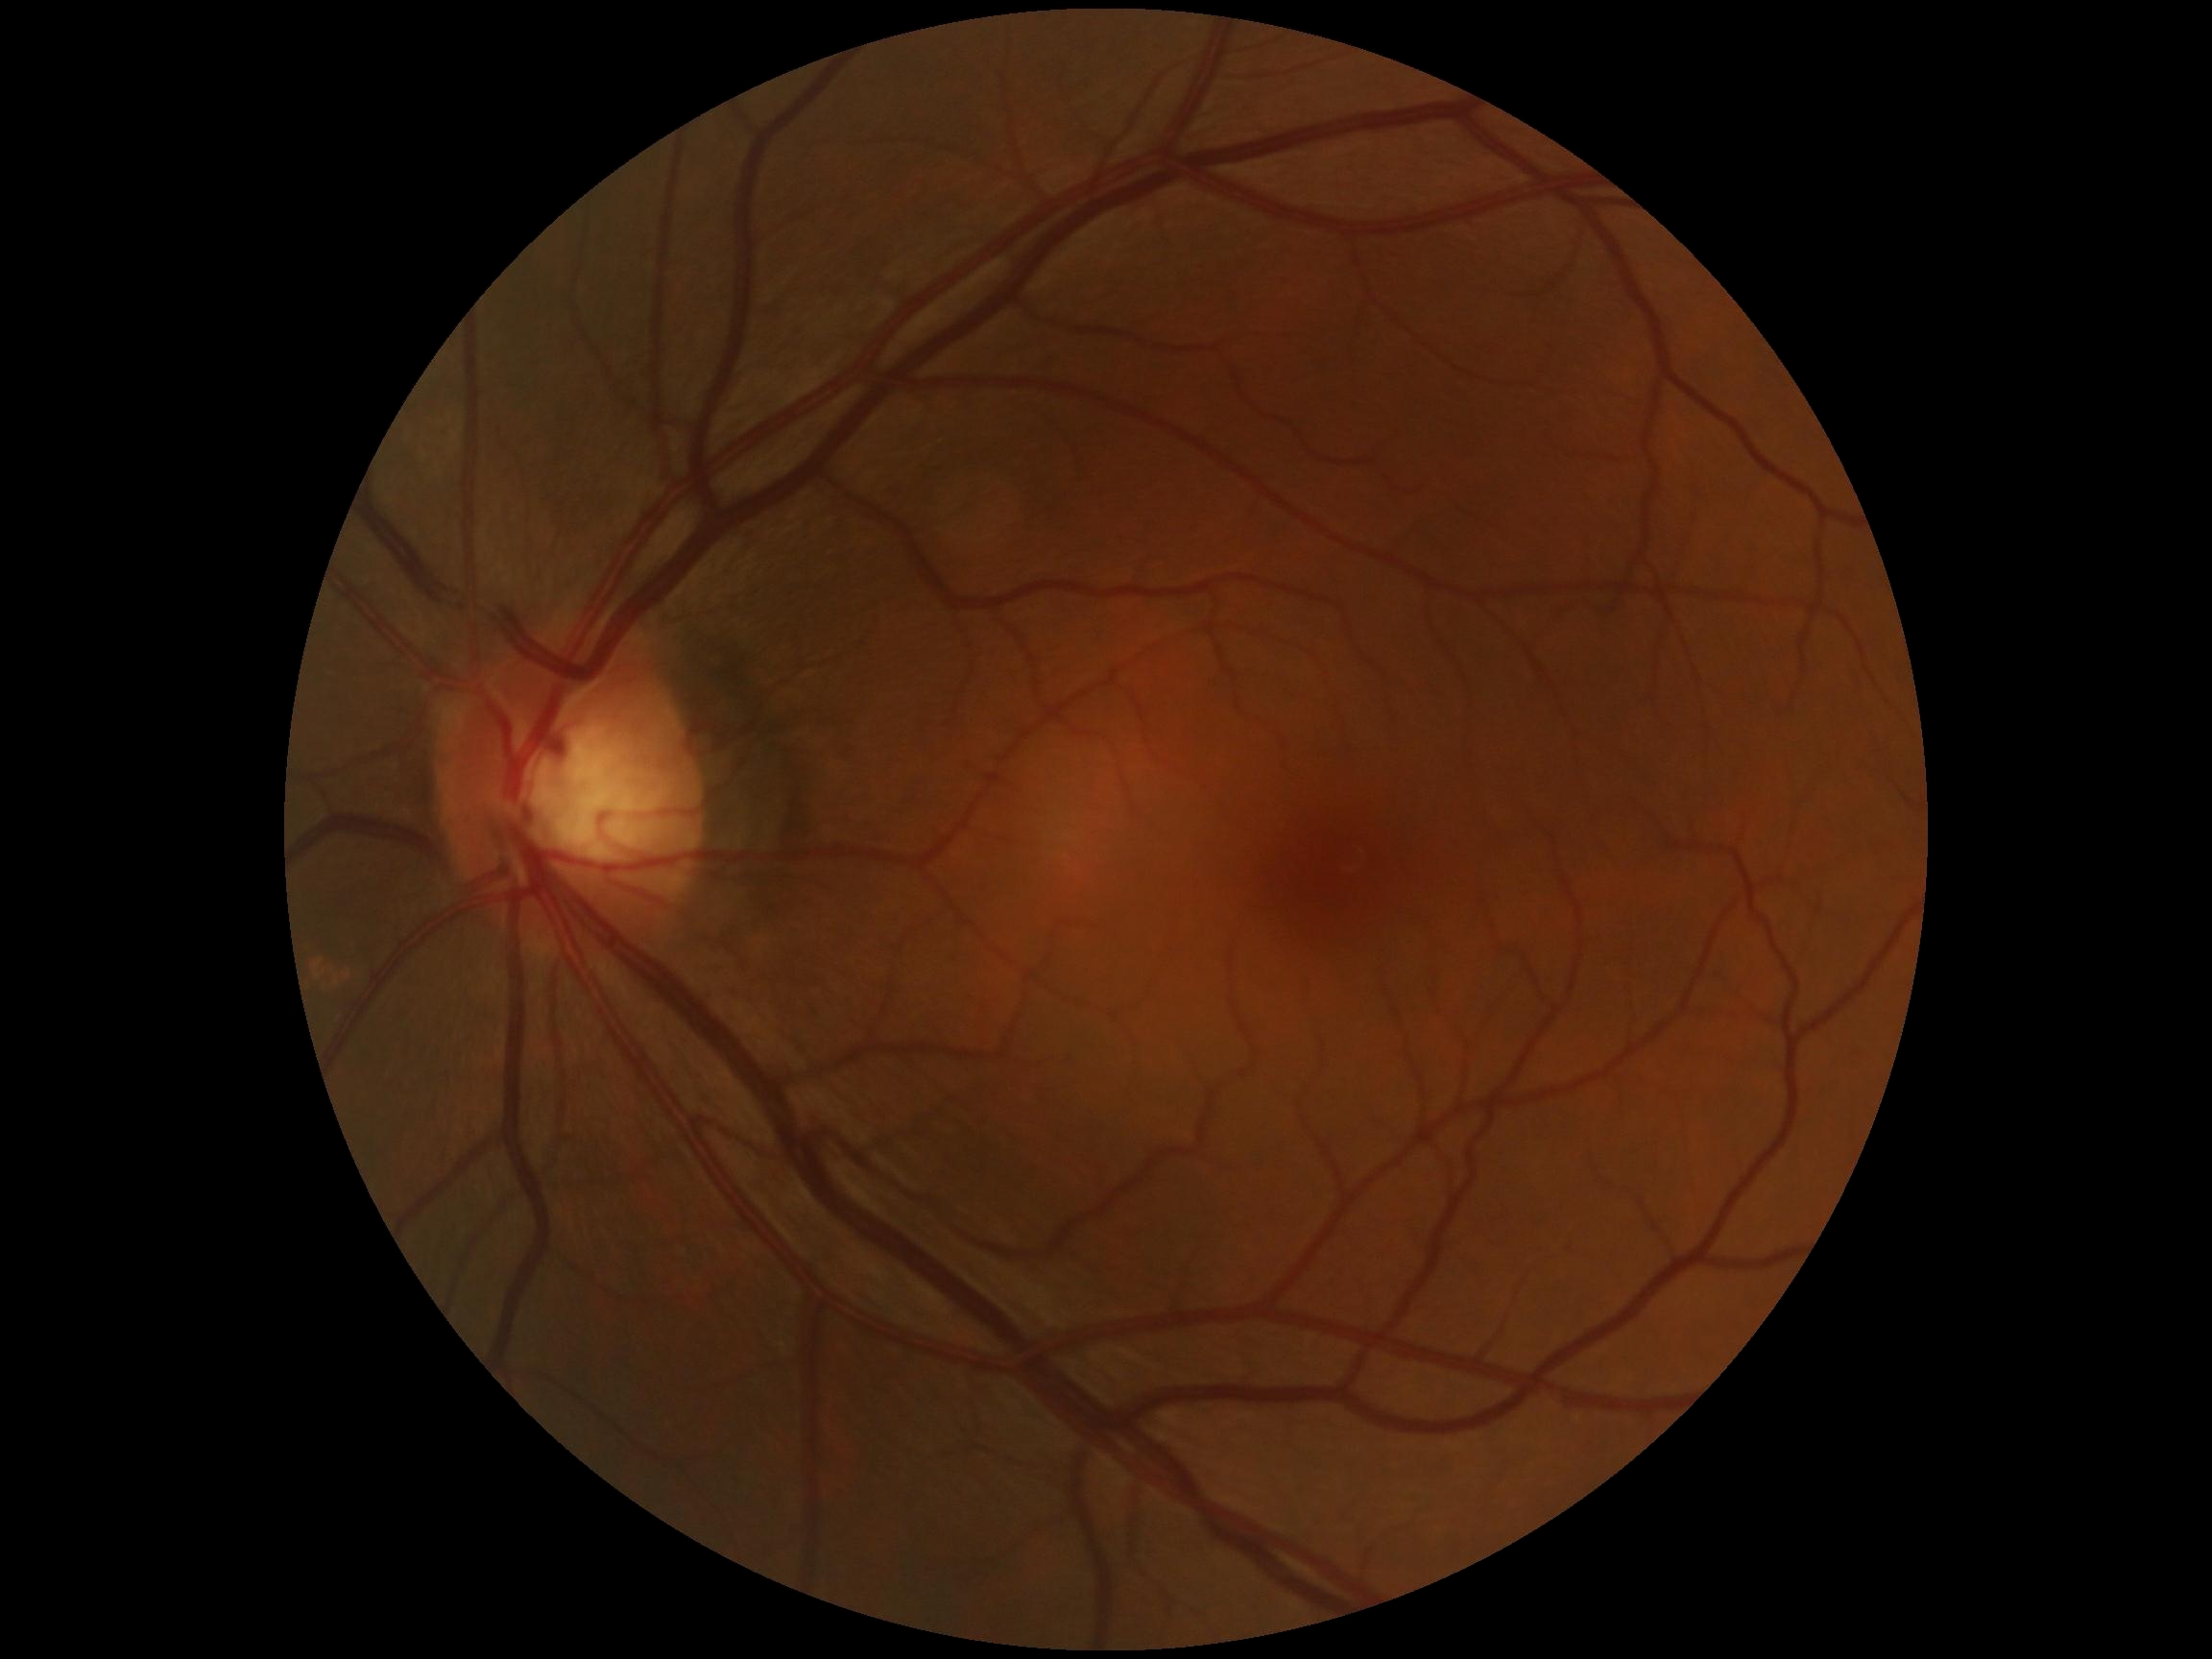
diabetic retinopathy = no apparent diabetic retinopathy (grade 0).